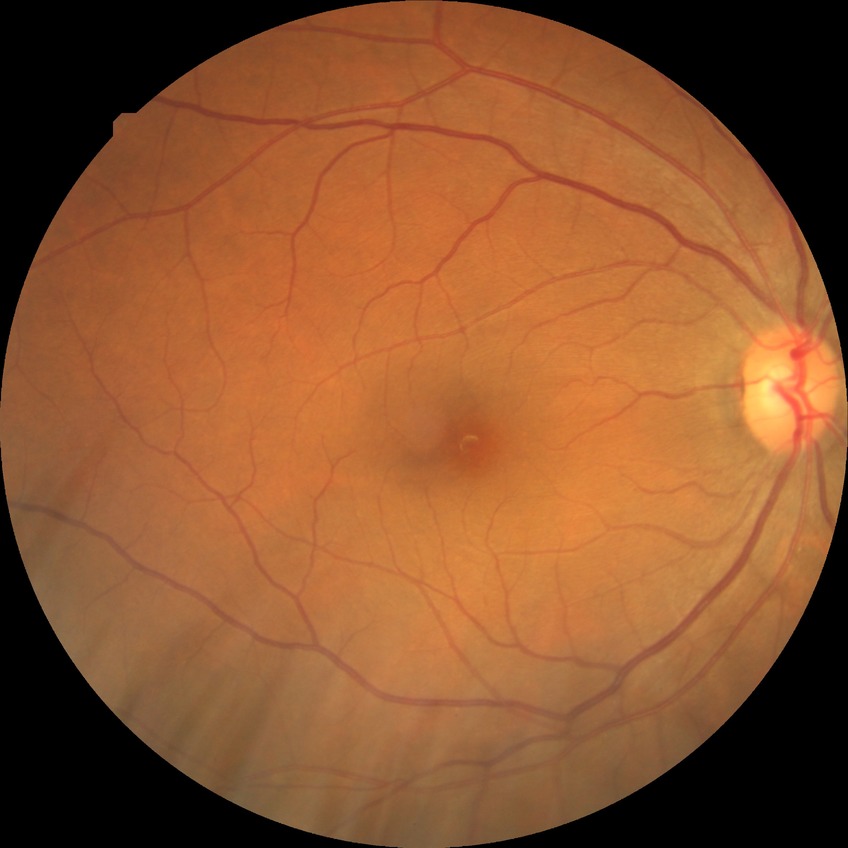
Diabetic retinopathy (DR): NDR (no diabetic retinopathy).